Wide-field contact fundus photograph of an infant — 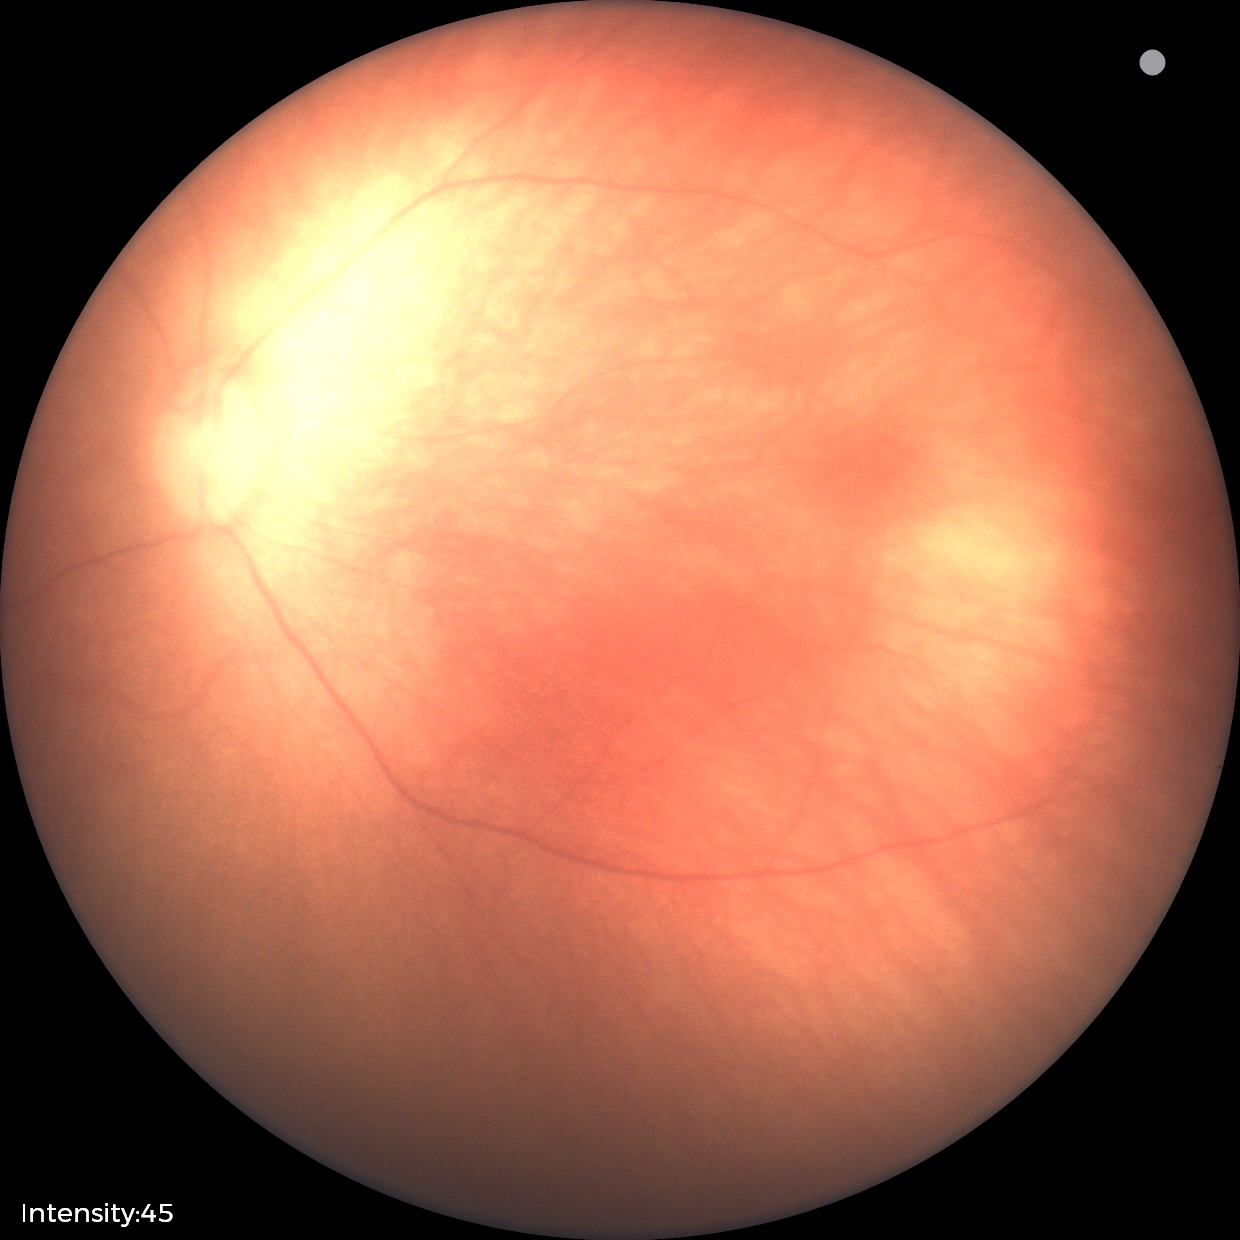

Normal screening examination.